Acquired on the Clarity RetCam 3. Wide-field fundus photograph of an infant. 640 by 480 pixels: 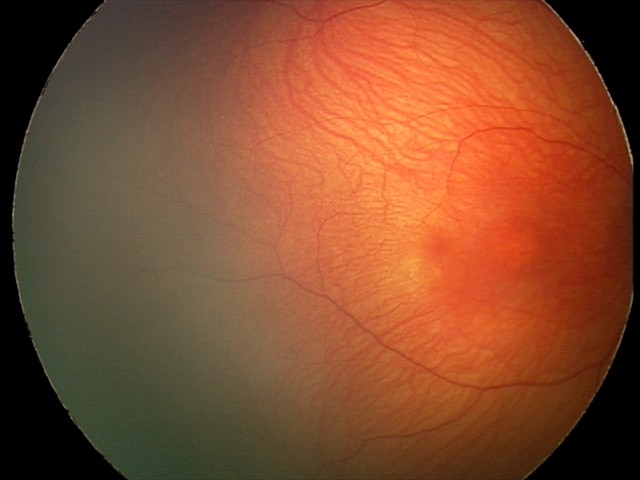 Examination with physiological retinal findings.